45° FOV · CFP · 2352x1568: 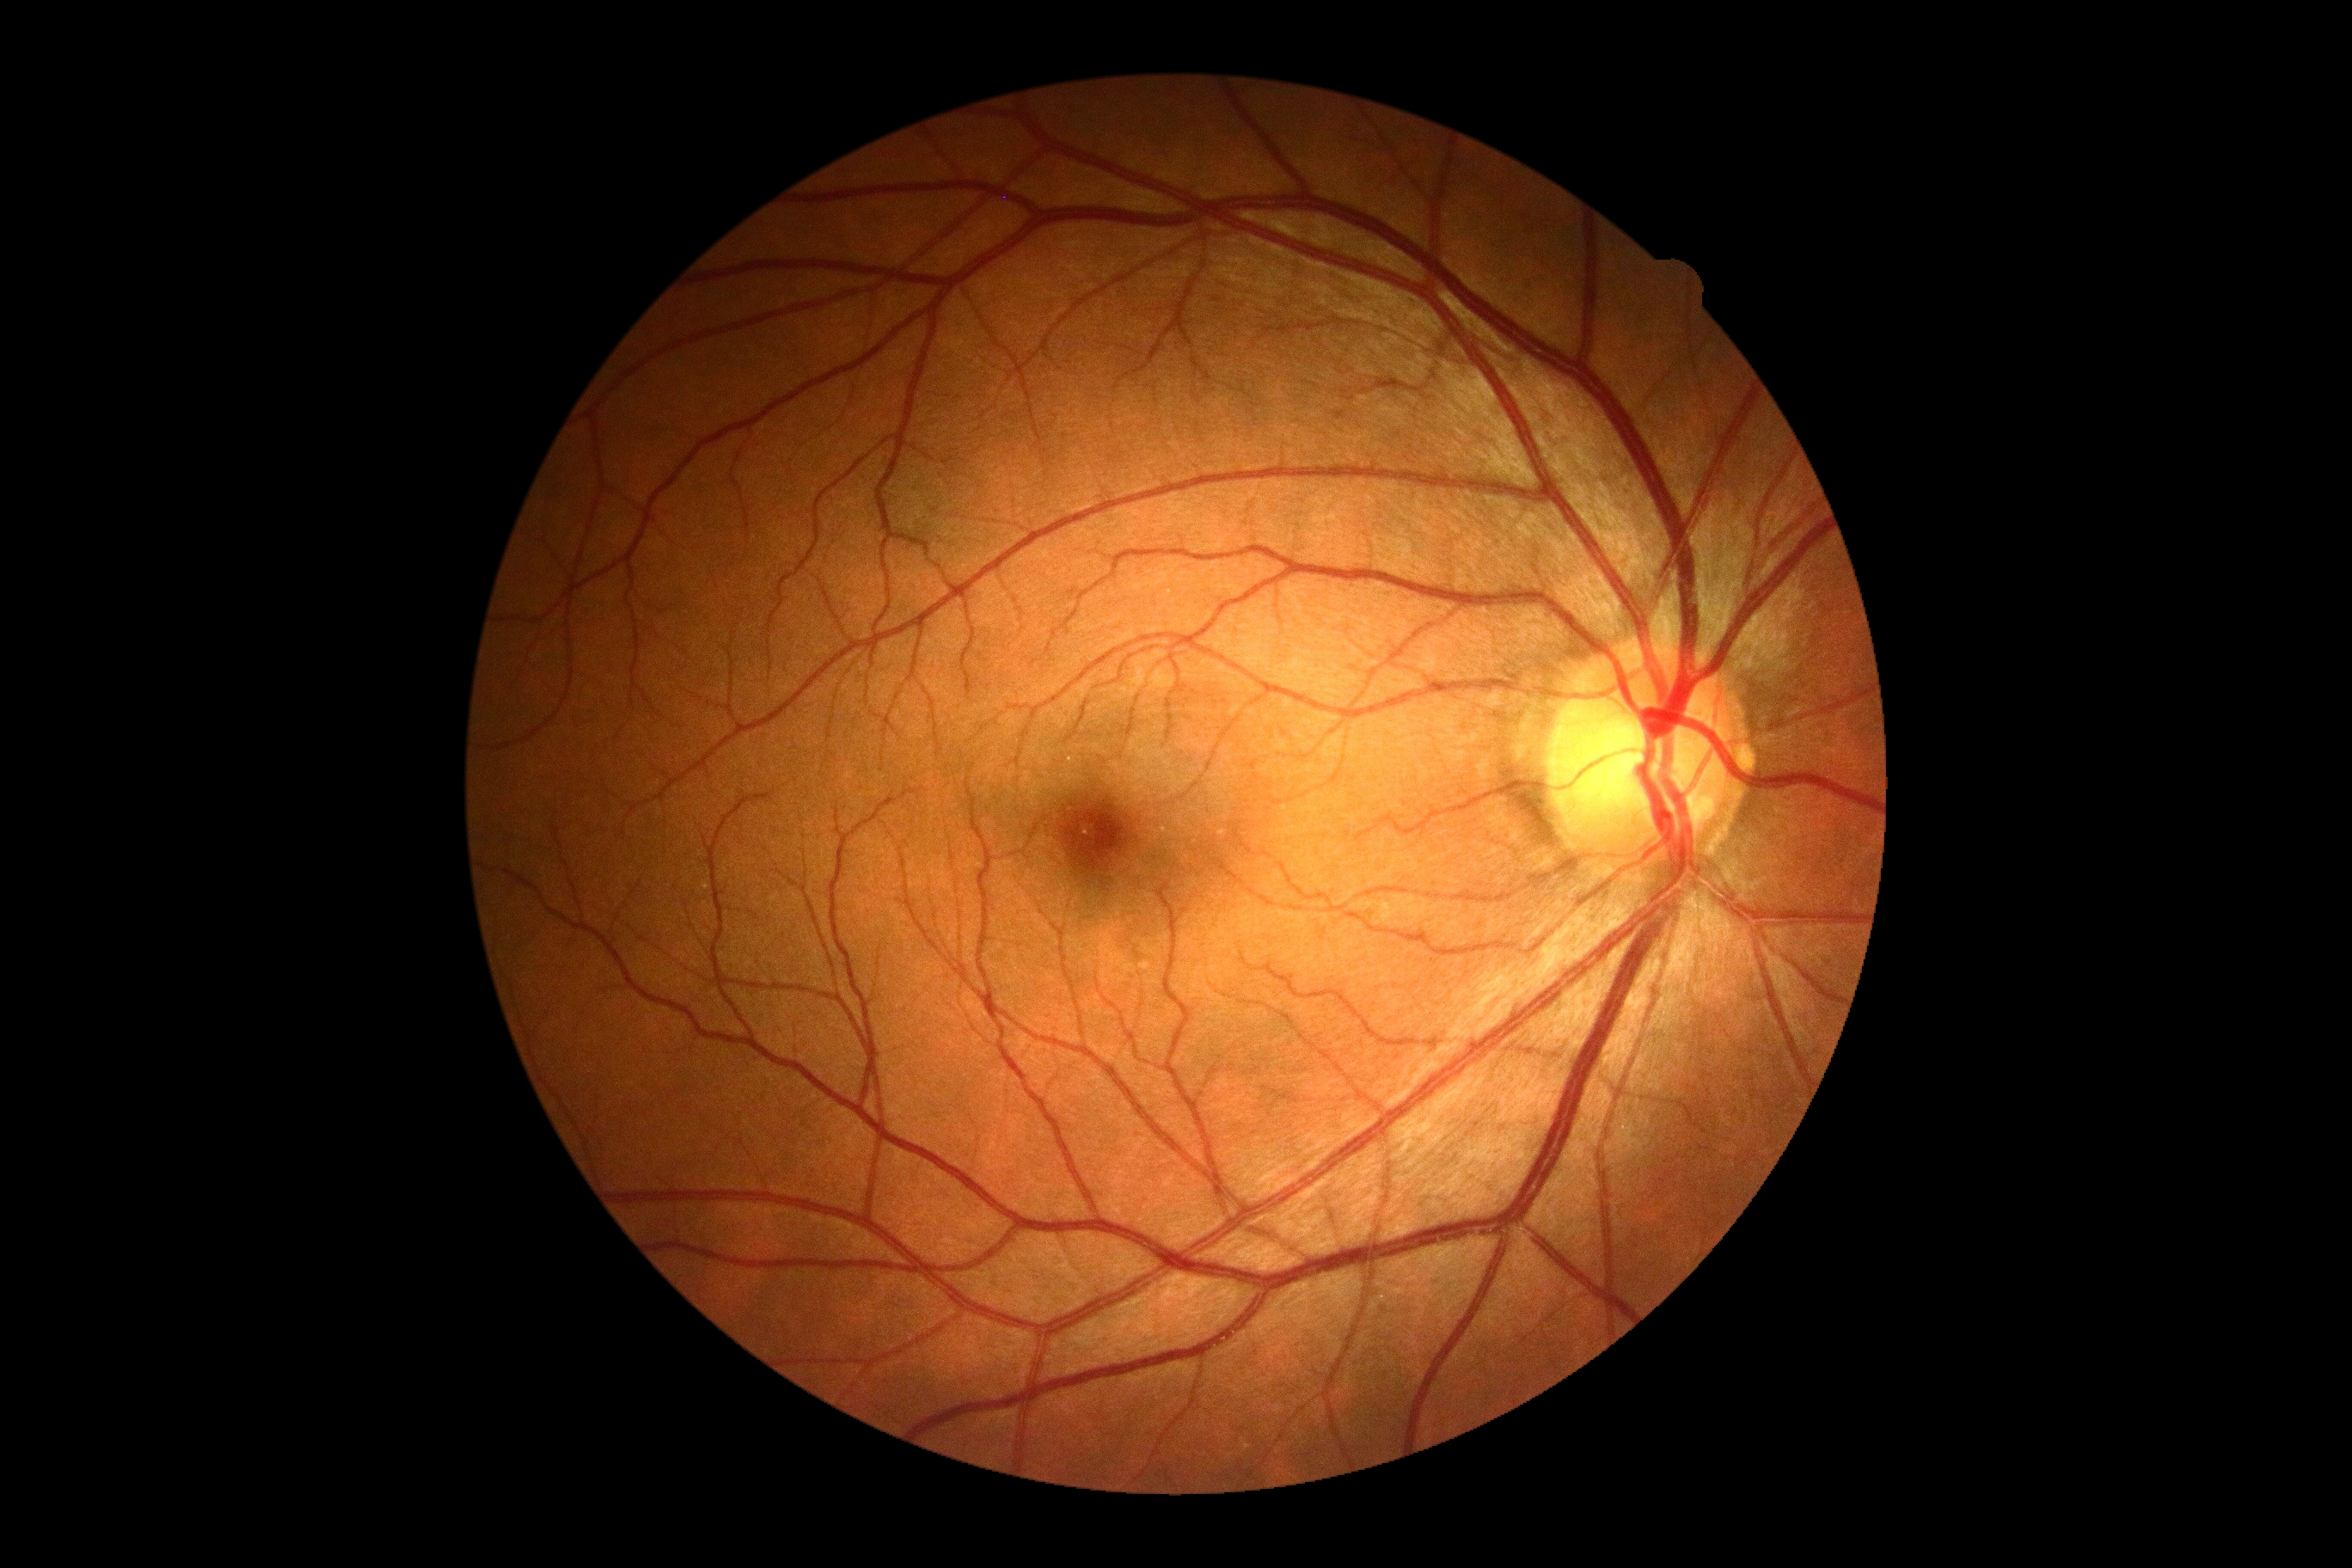 Retinopathy: grade 0.